Wide-field fundus photograph of an infant:
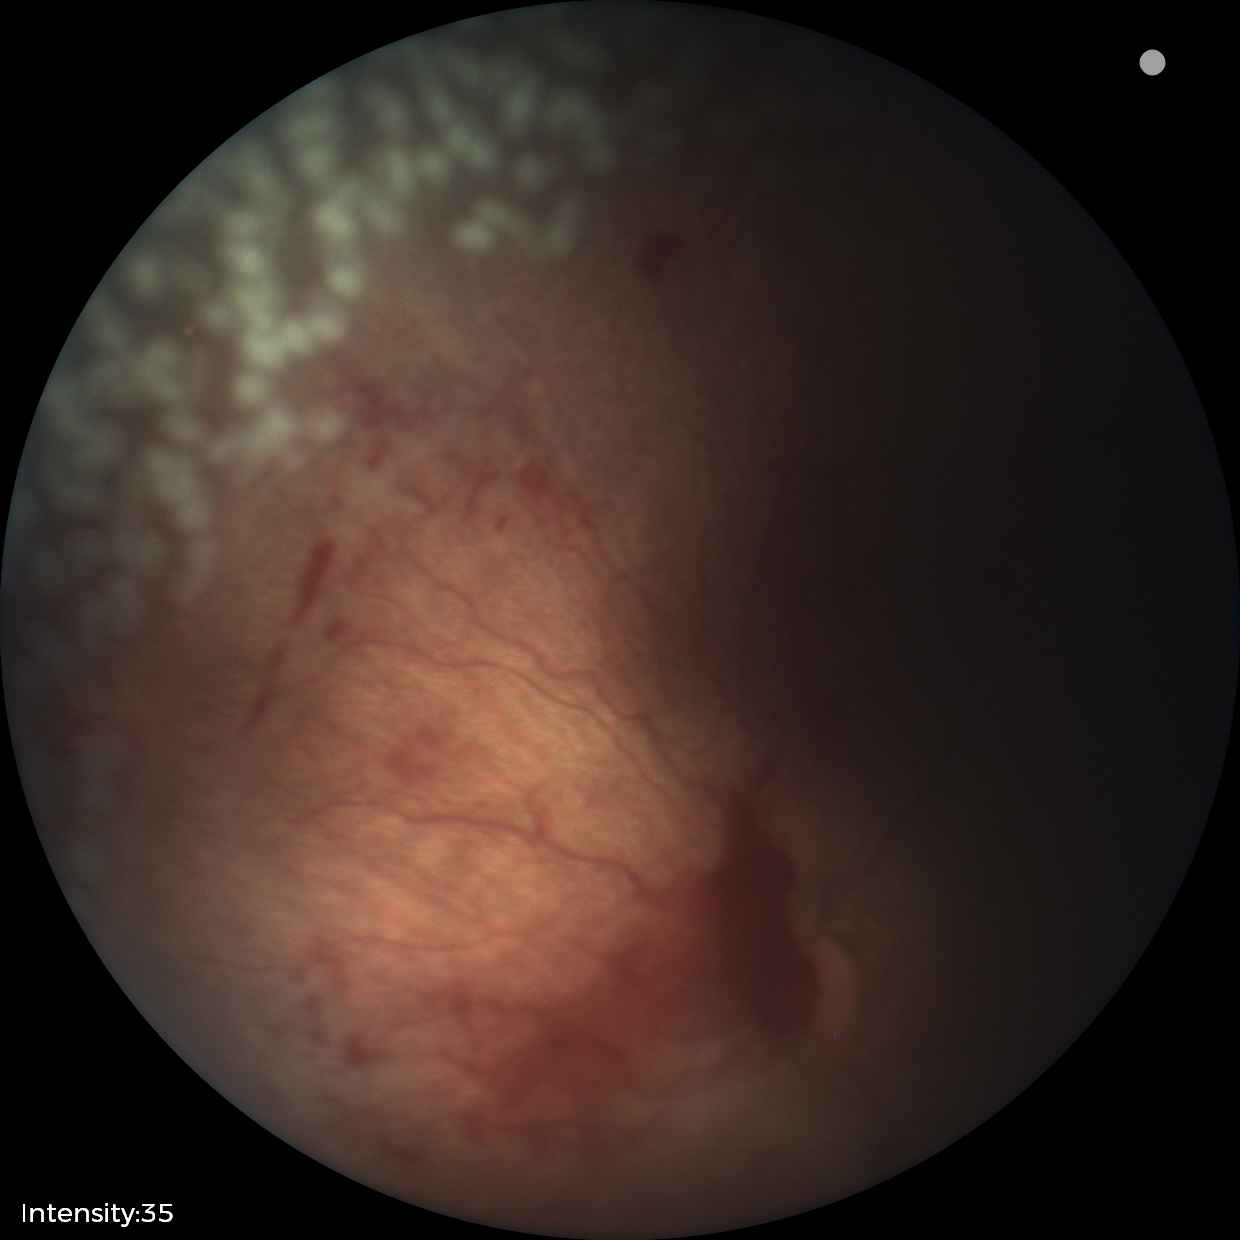
Assessment: ROP stage 2 | plus disease.